Ultra-widefield fundus mosaic
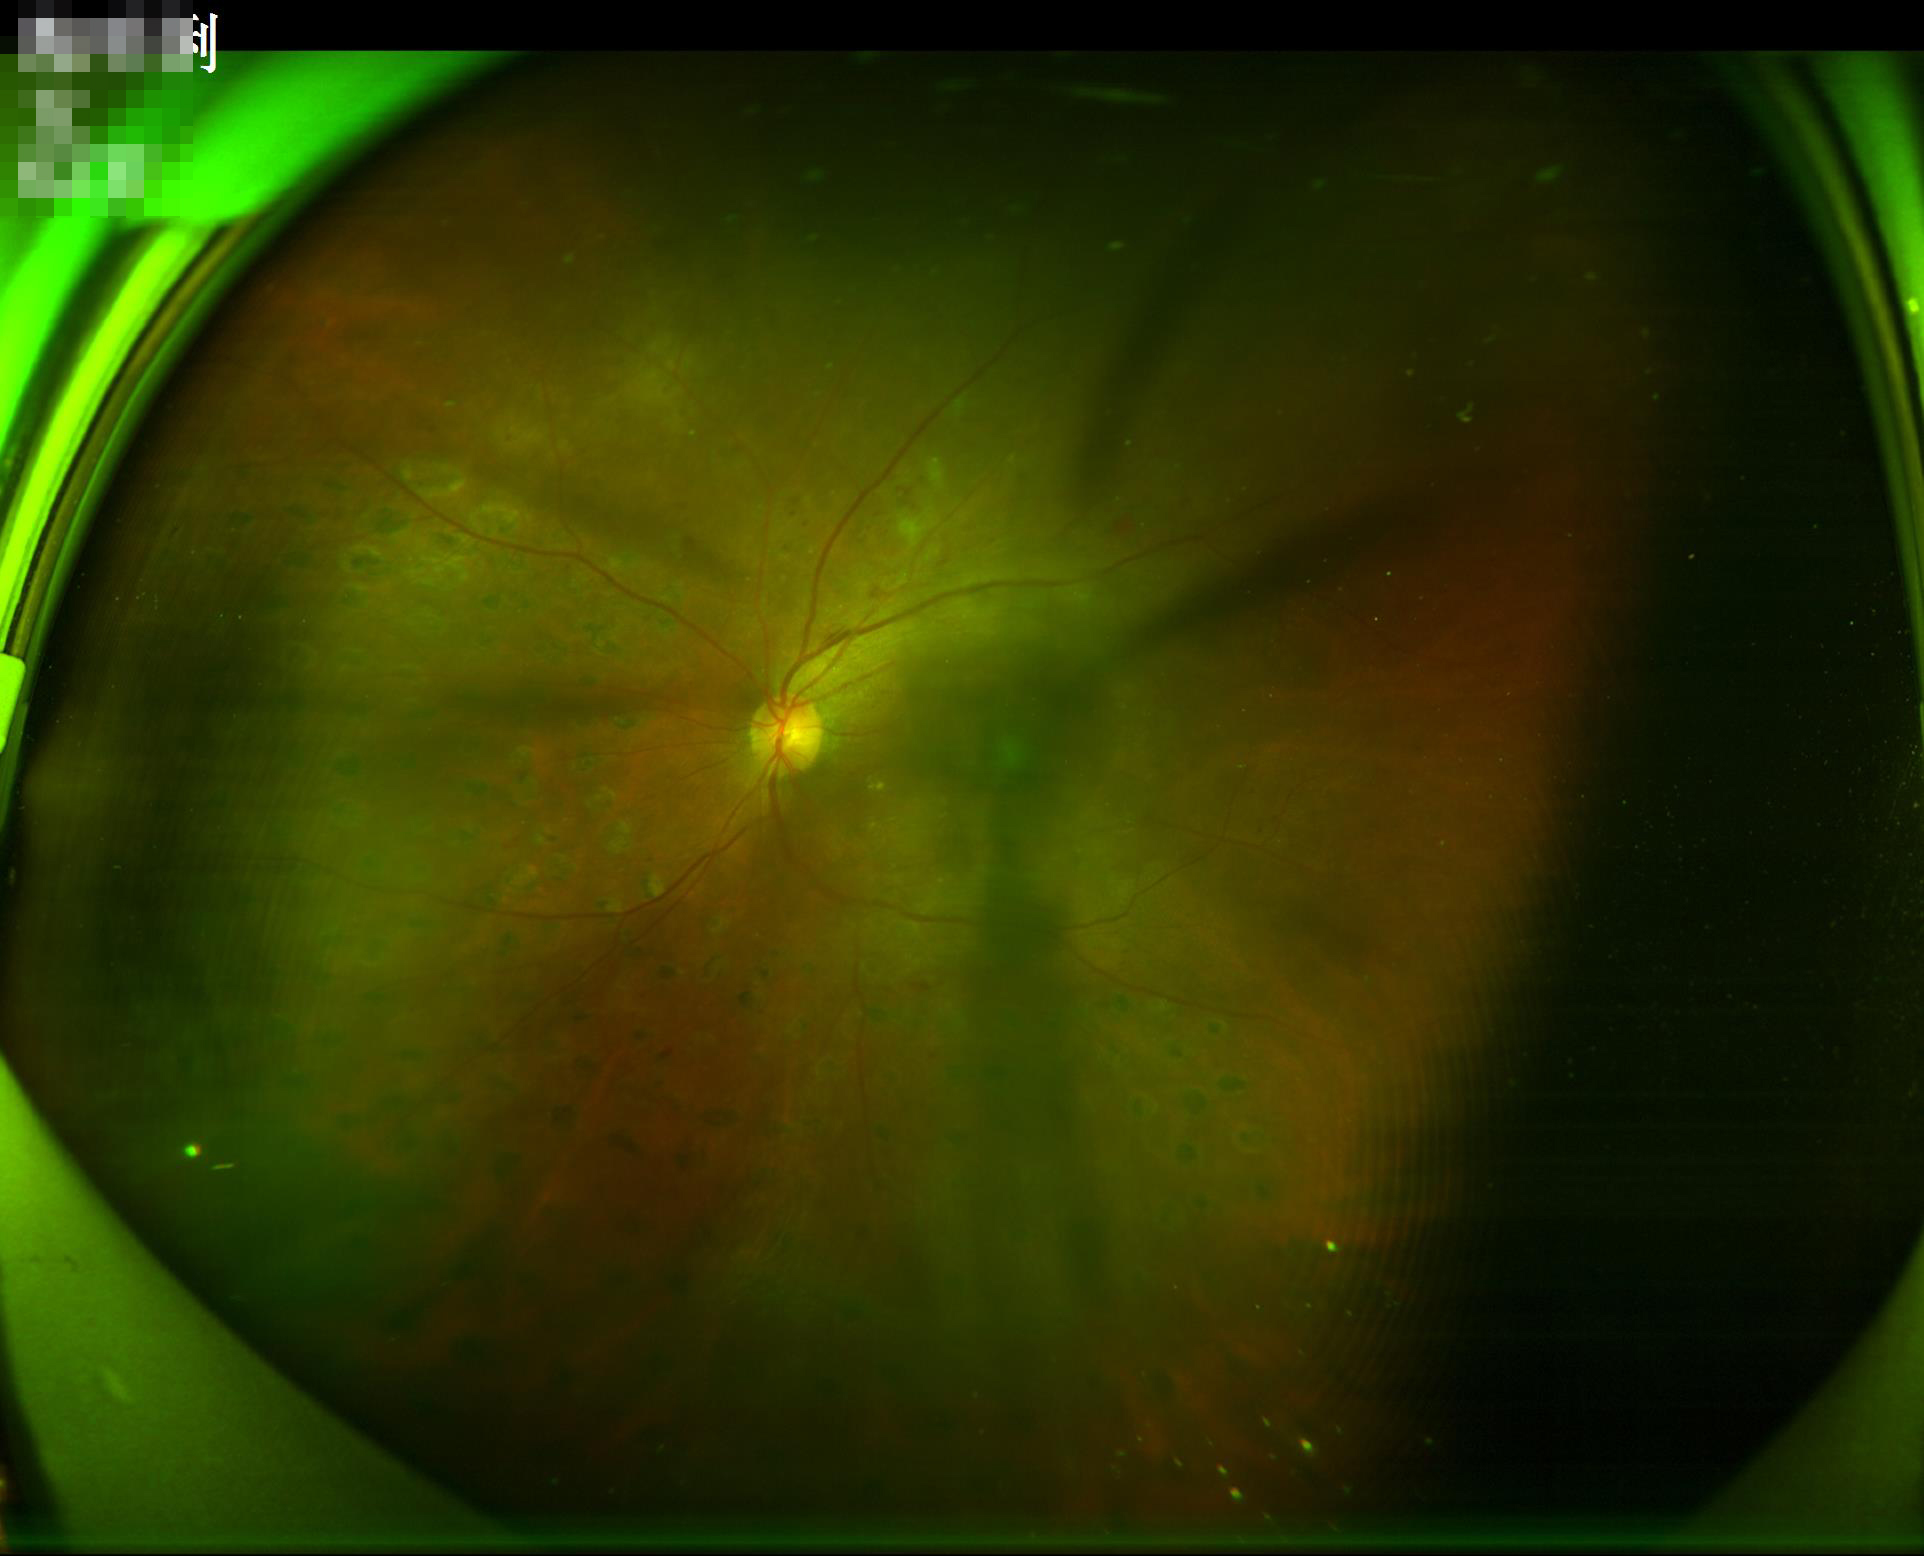

Image quality is inadequate for diagnostic use. Good dynamic range. No noticeable blur. There is over- or under-exposure or a color cast.